Fundus photo: 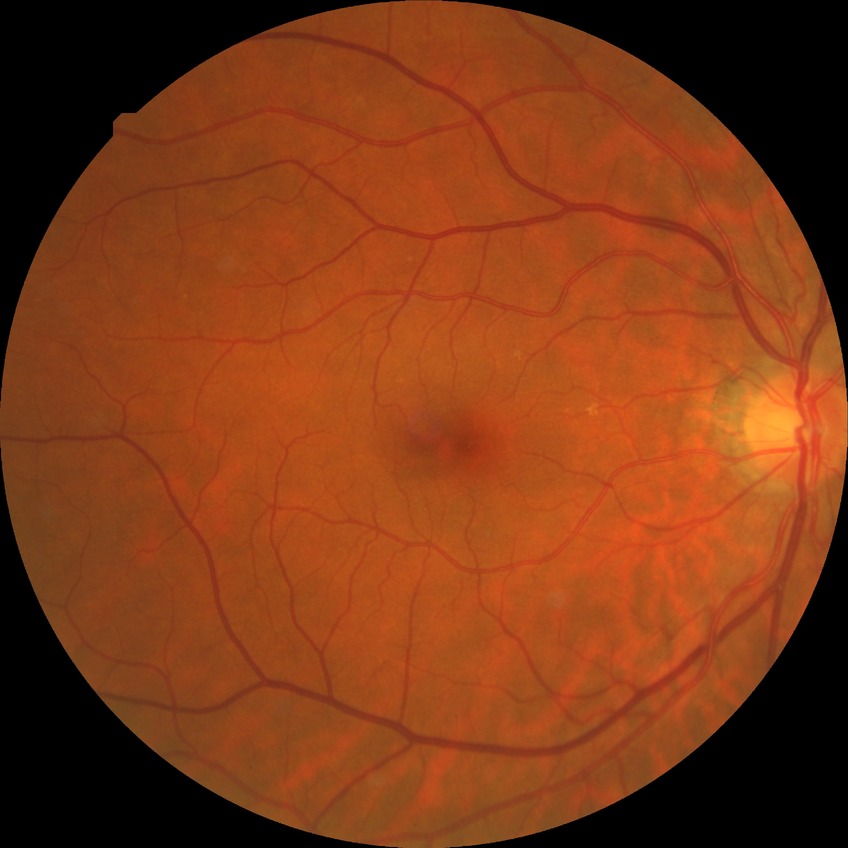
Modified Davis classification is no diabetic retinopathy.